Color fundus image; 1624x1232px:
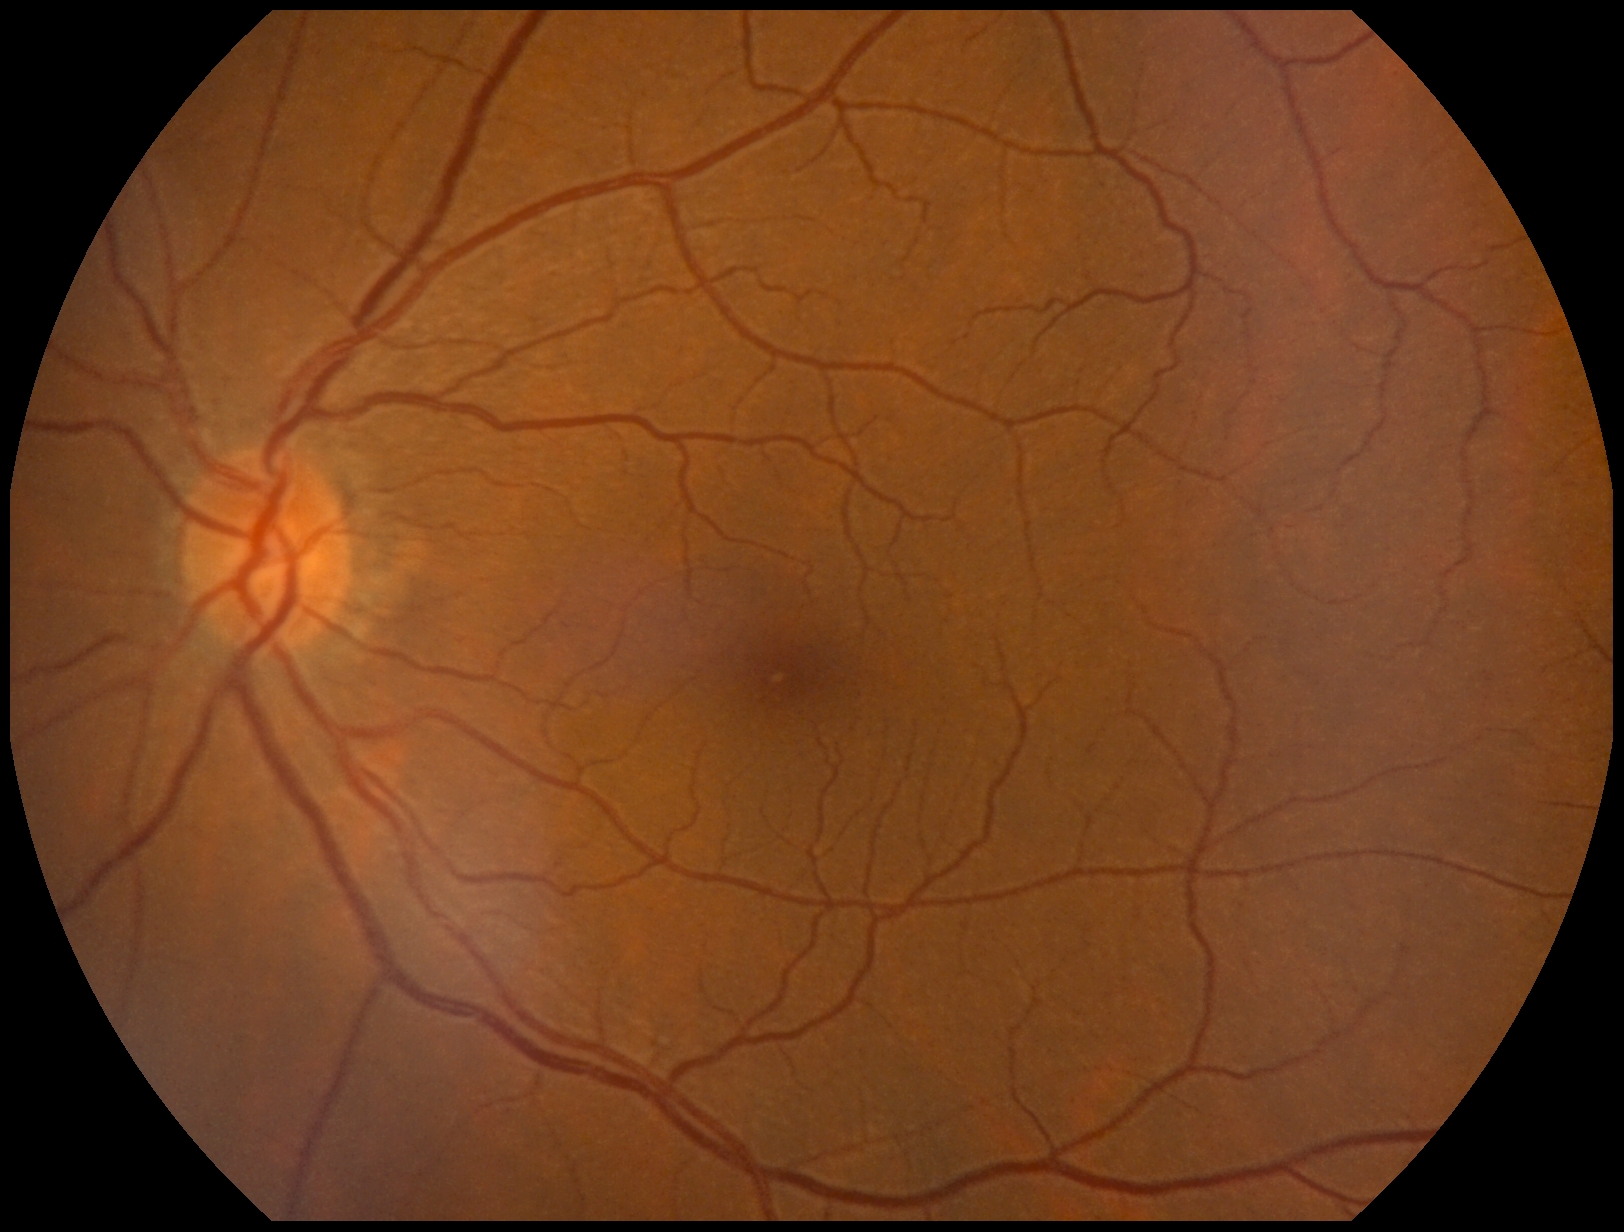
DR = grade 0.